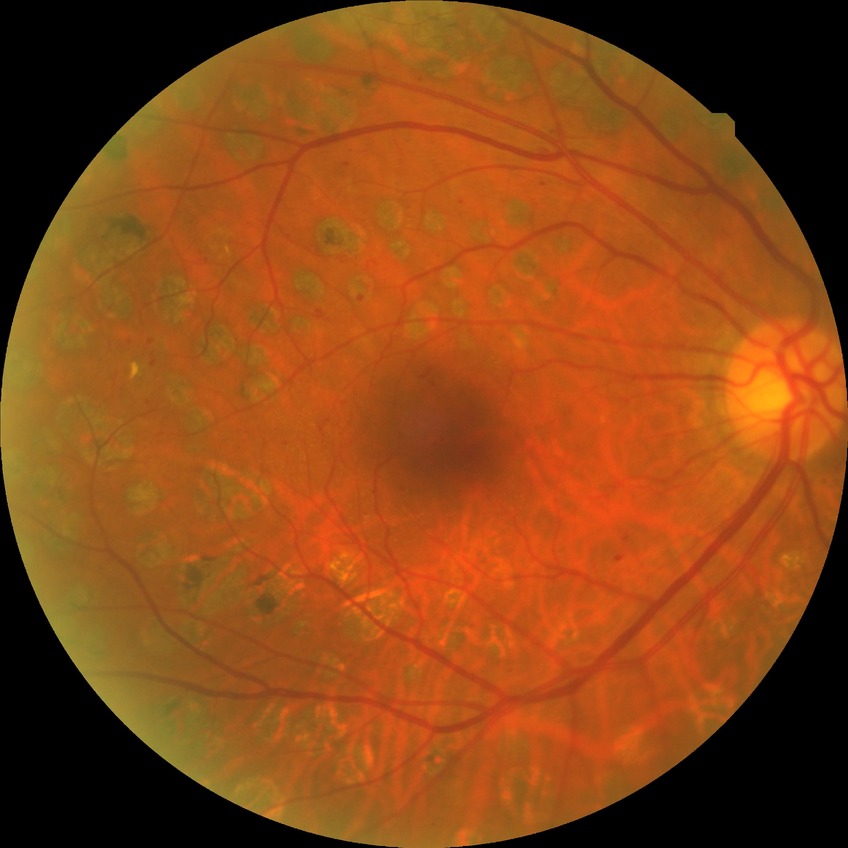
modified Davis grade@PDR.